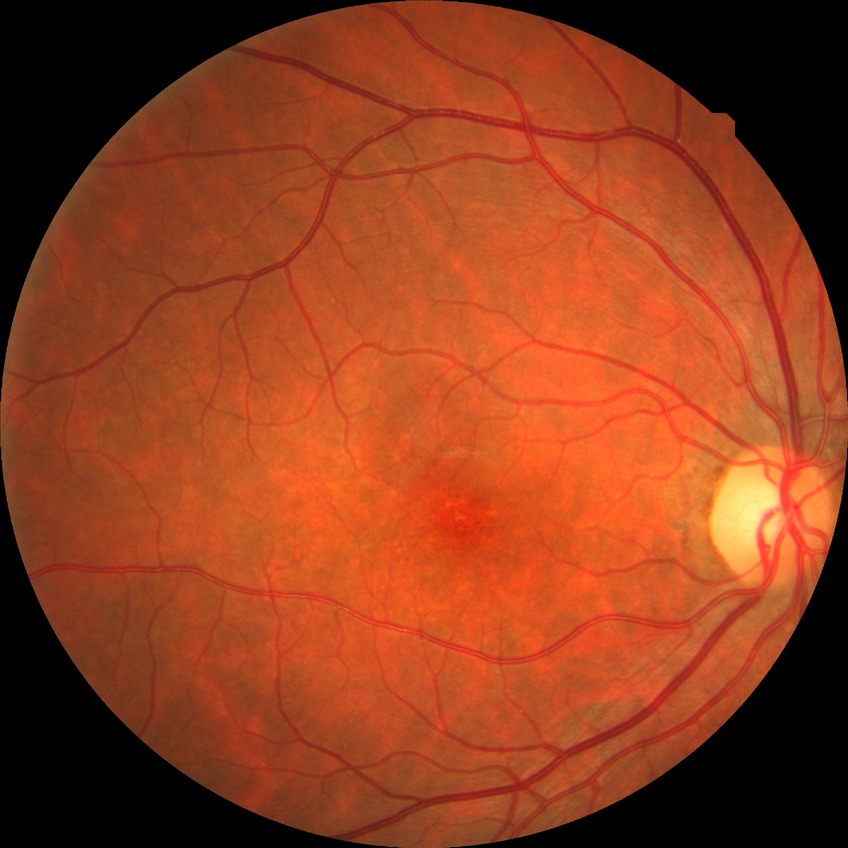 Assessment:
- Davis DR grade — NDR
- DR impression — no signs of DR